Corneal thickness: 485 µm; age 65; autorefraction: +1.25 -0.75 x 105; captured without pupil dilation — 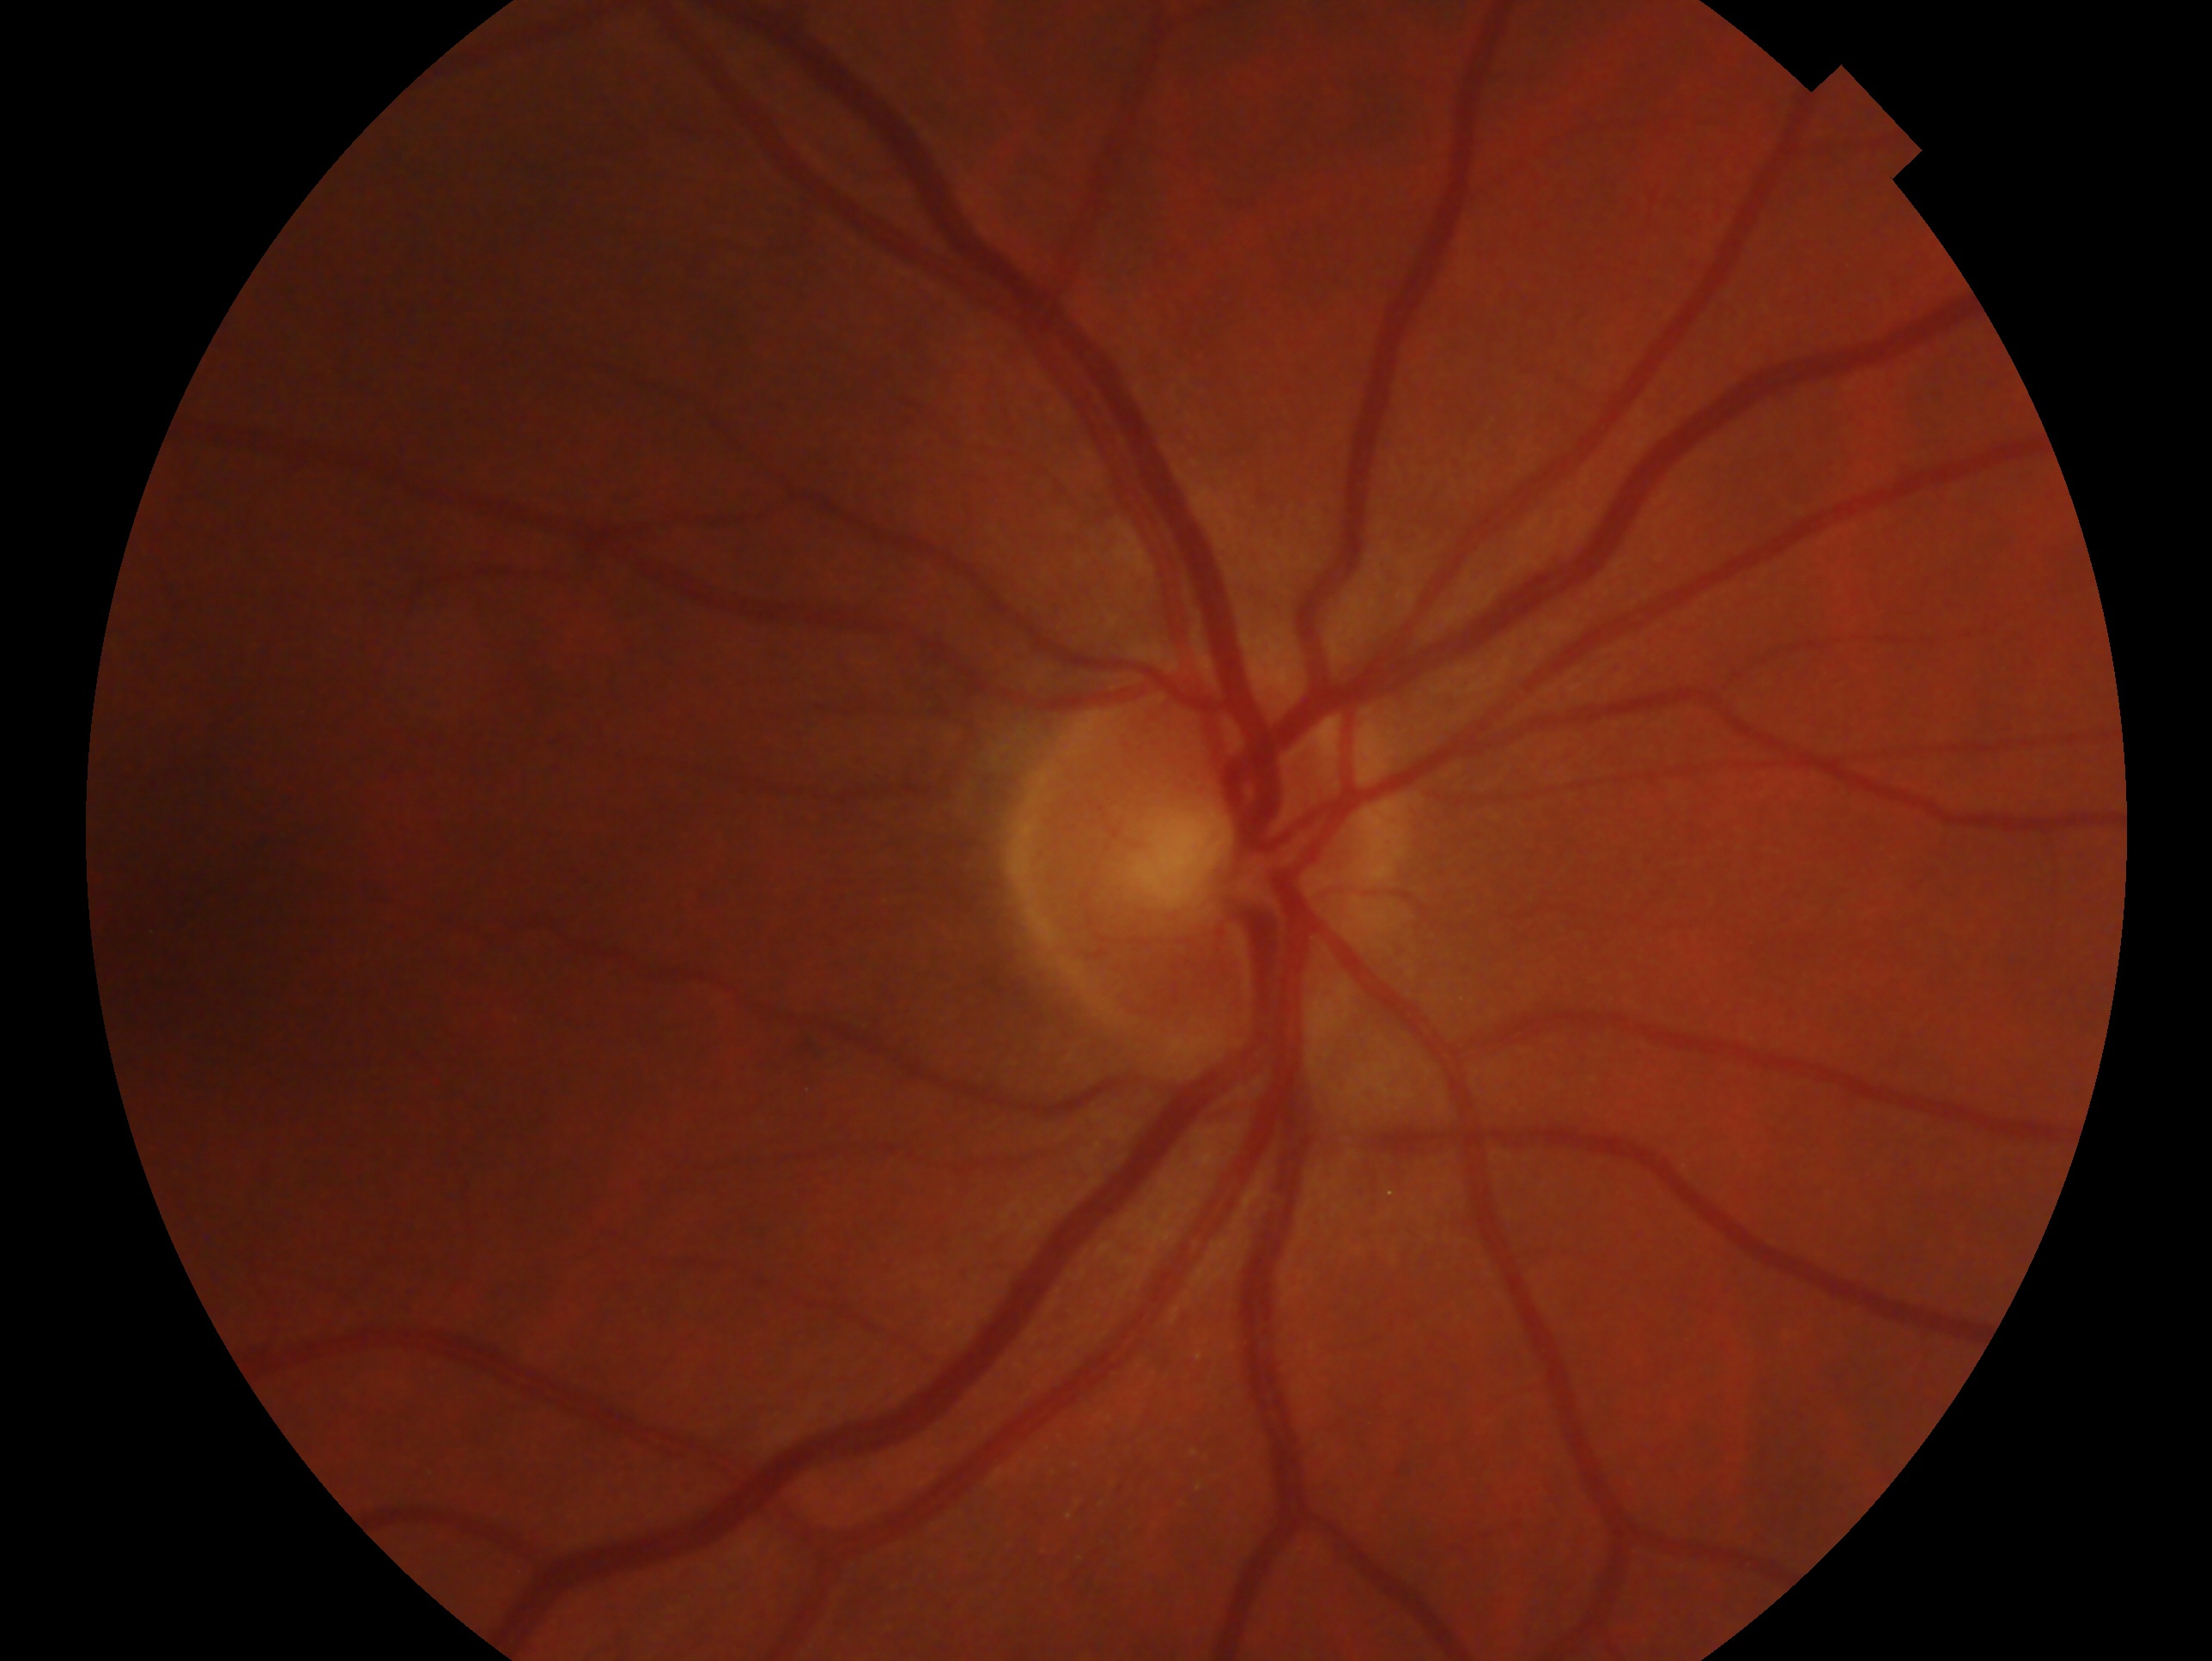
Glaucoma assessment: negative for glaucoma. This is the OD.